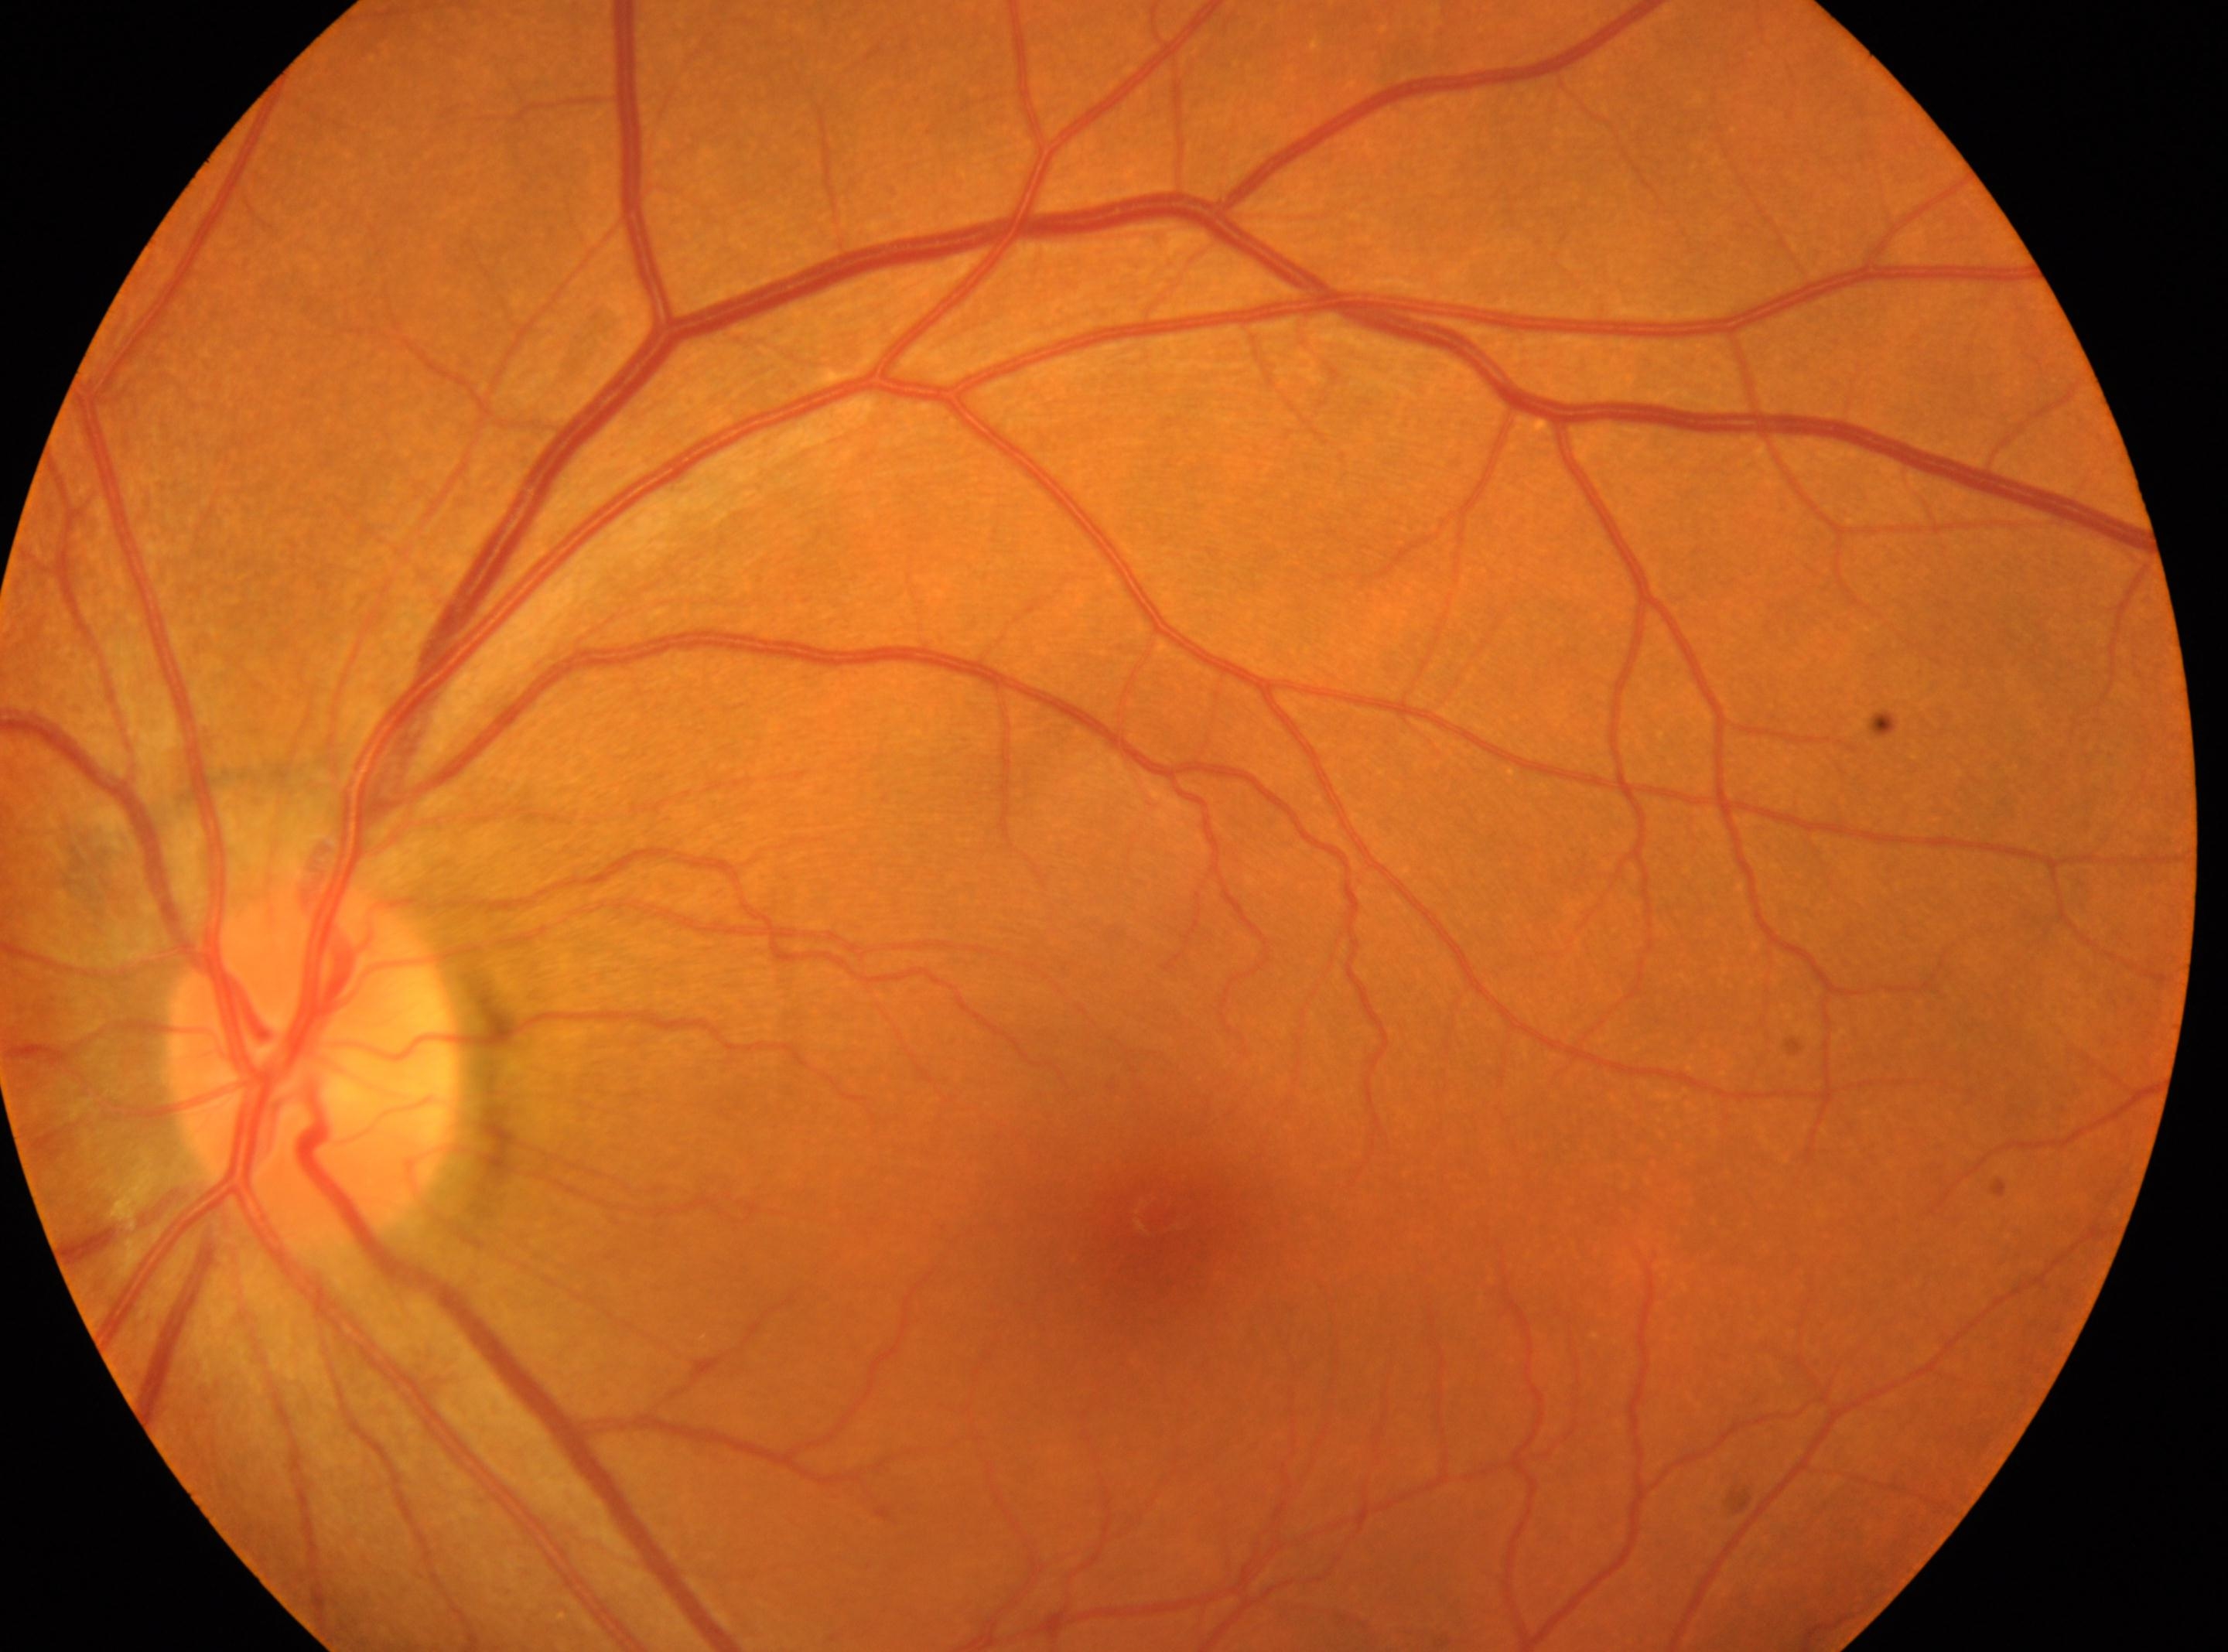 Diabetic retinopathy (DR) is 0/4.
The fovea centralis is at [1156, 1211].
The image shows the left eye.
Optic disc center located at [312, 1064].